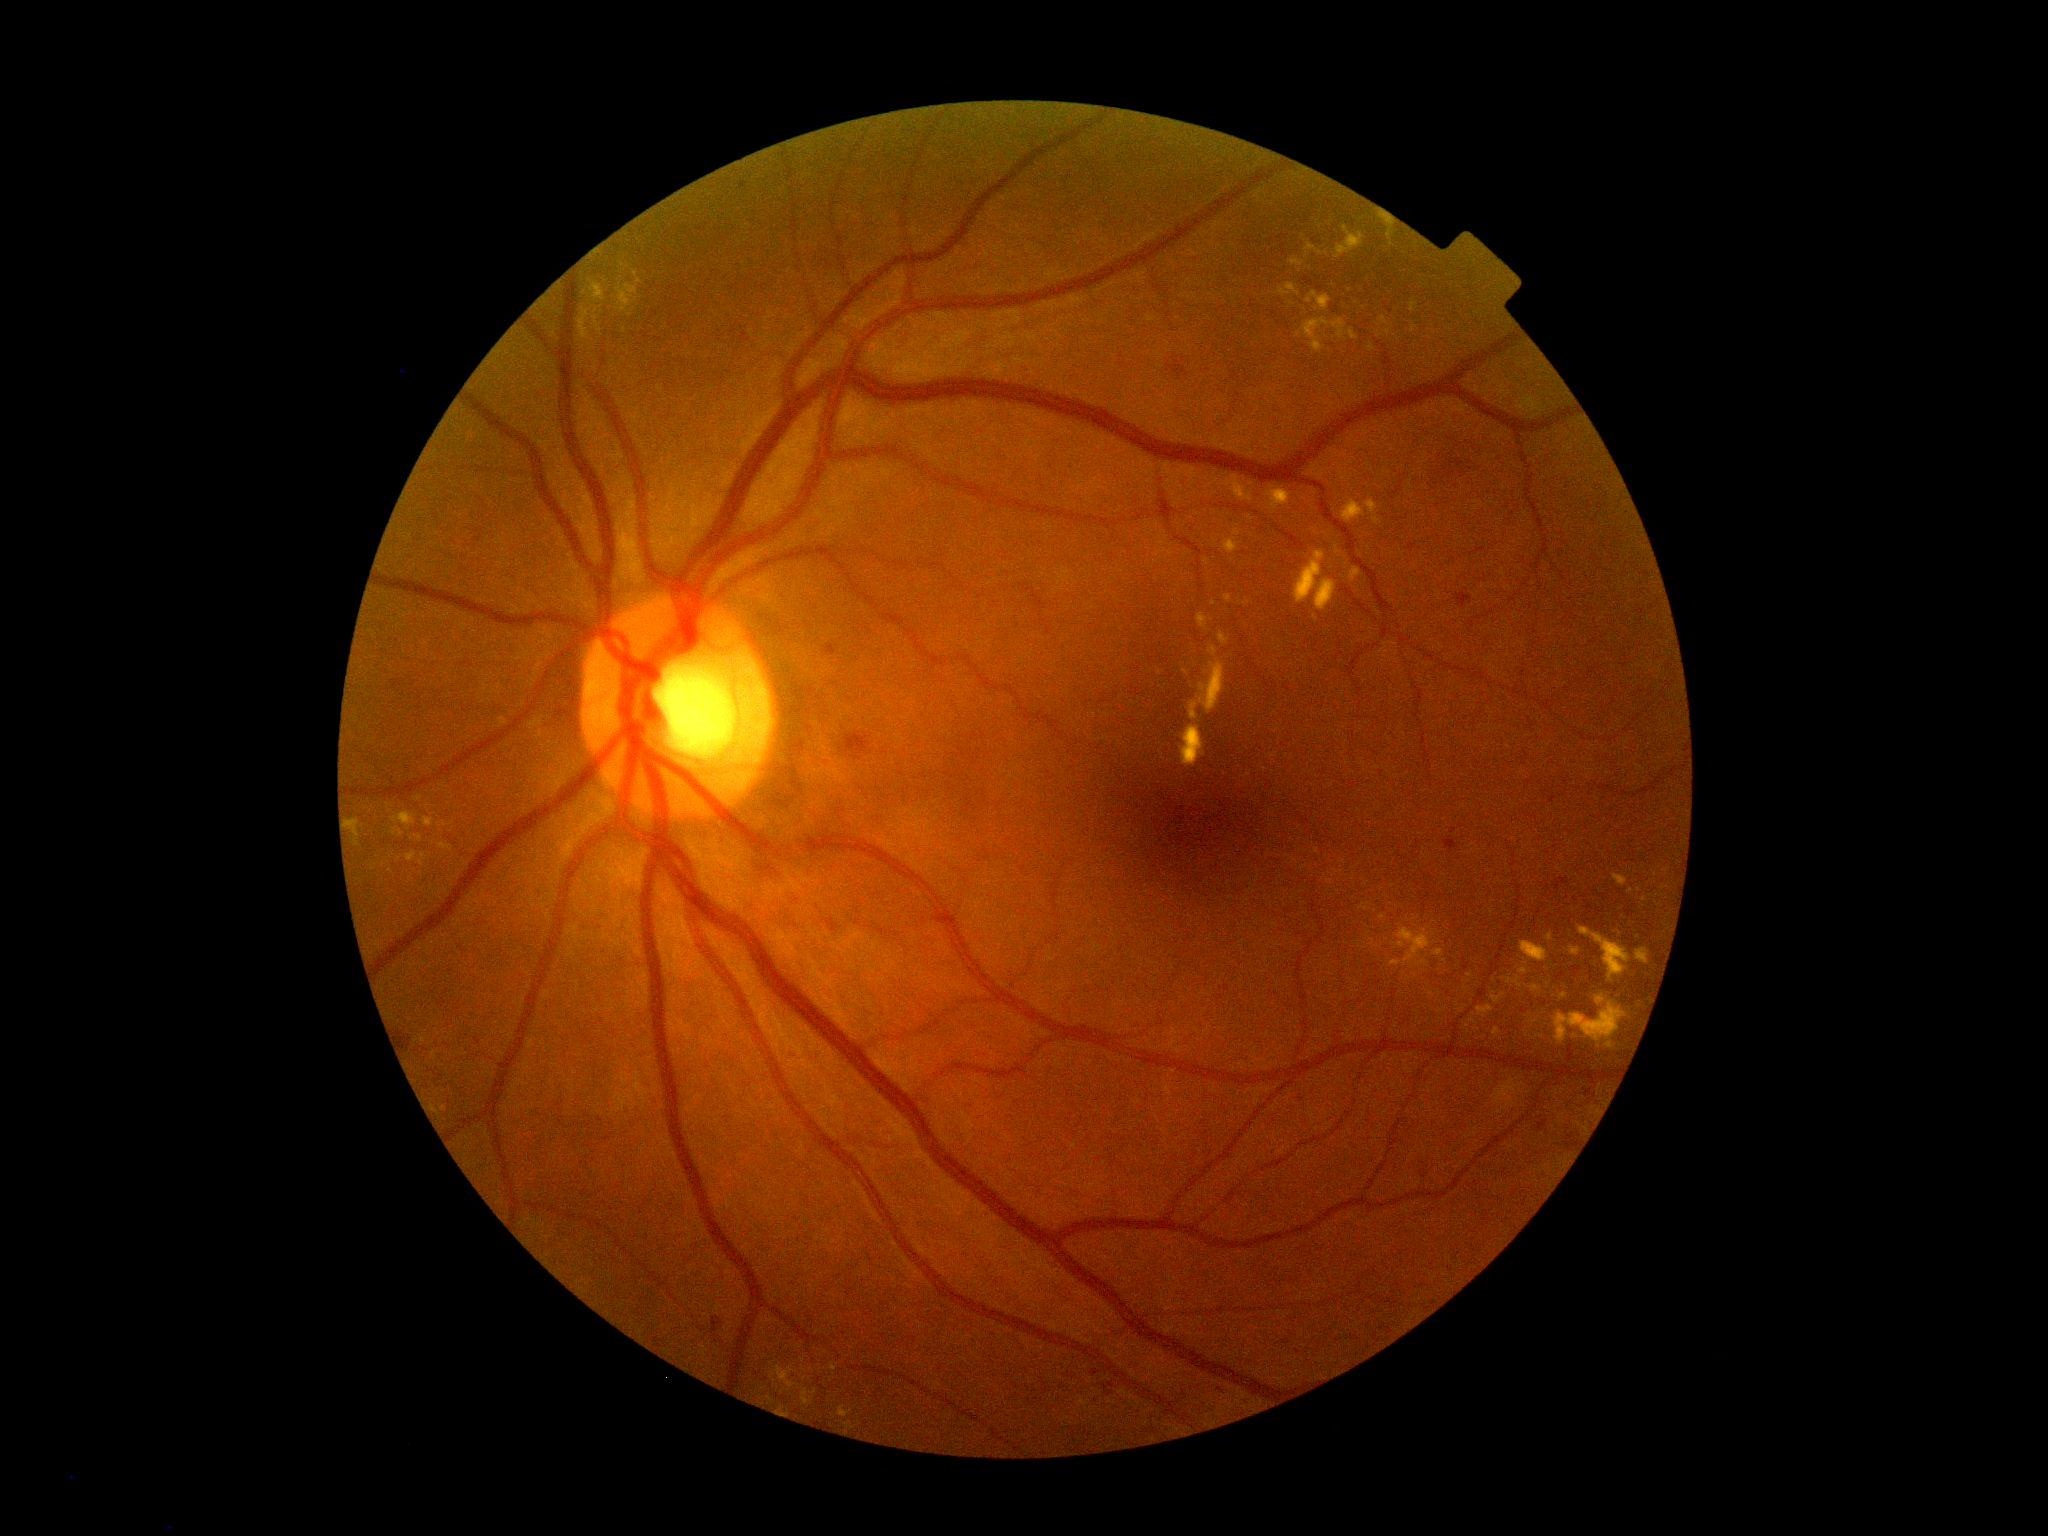
DR class: non-proliferative diabetic retinopathy. Diabetic retinopathy (DR) is moderate non-proliferative diabetic retinopathy (grade 2).